Man: 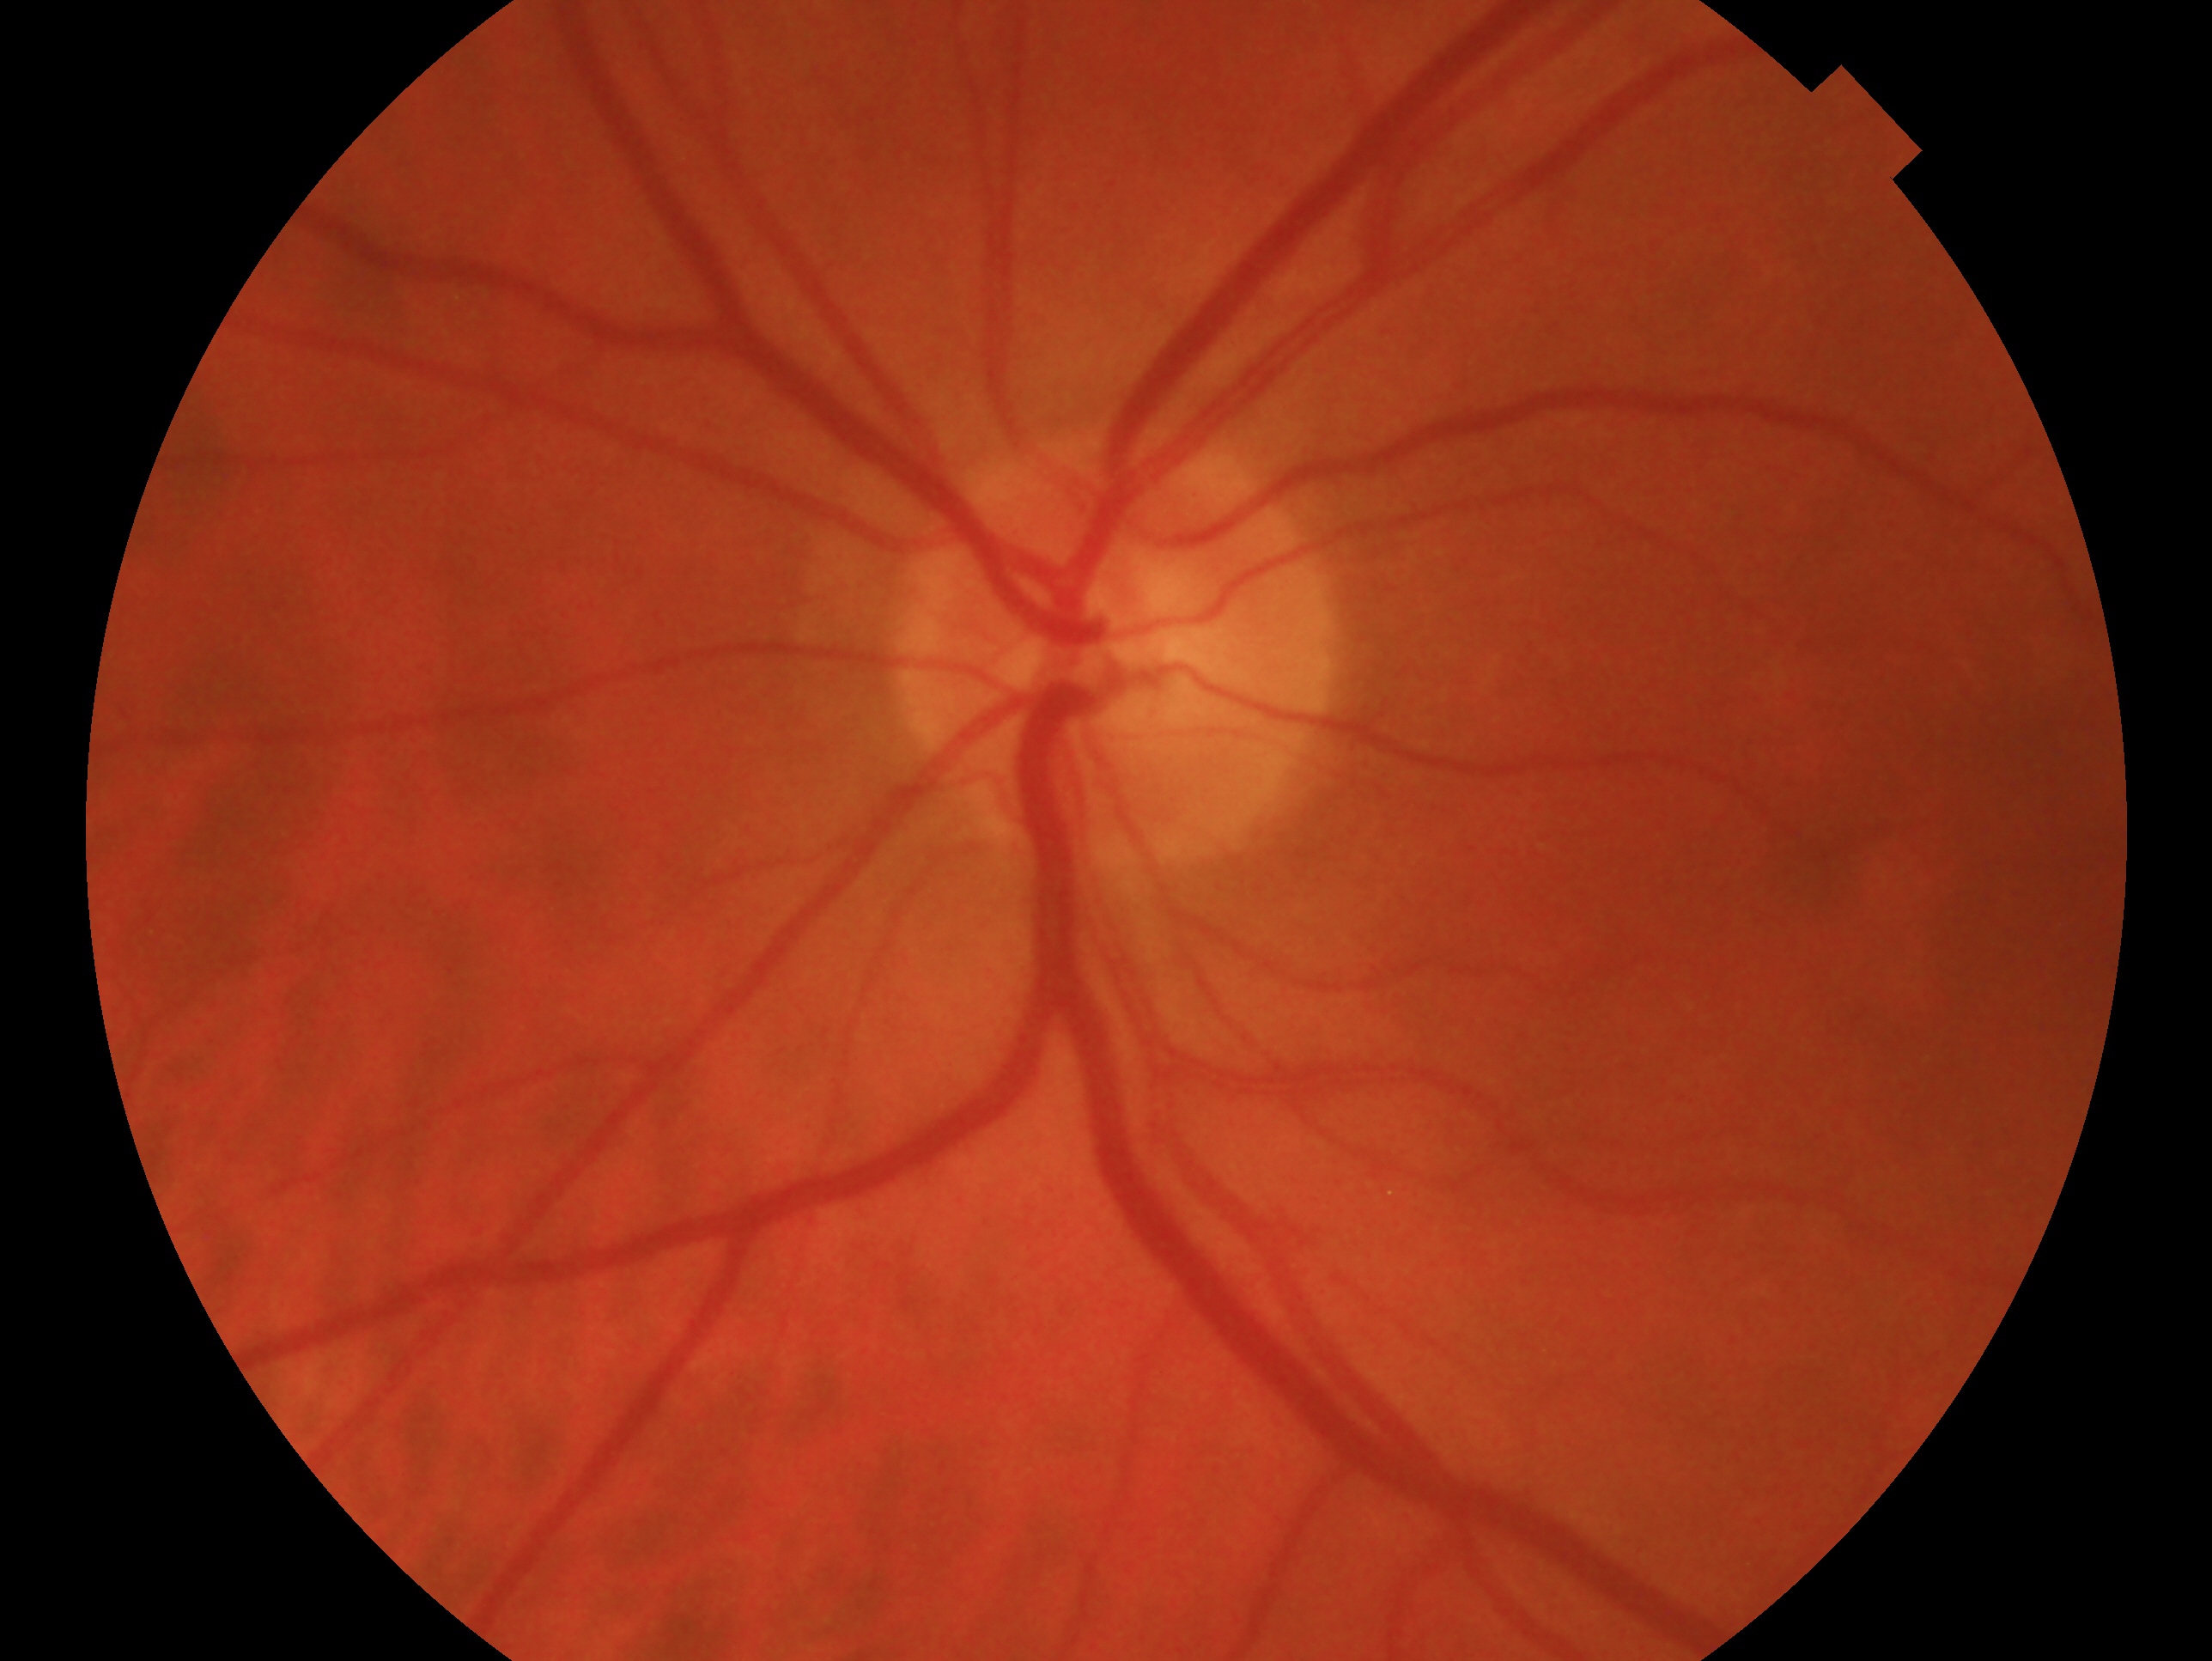 This is the left eye. Impression — negative for glaucoma.